RetCam wide-field infant fundus image · image size 640x480:
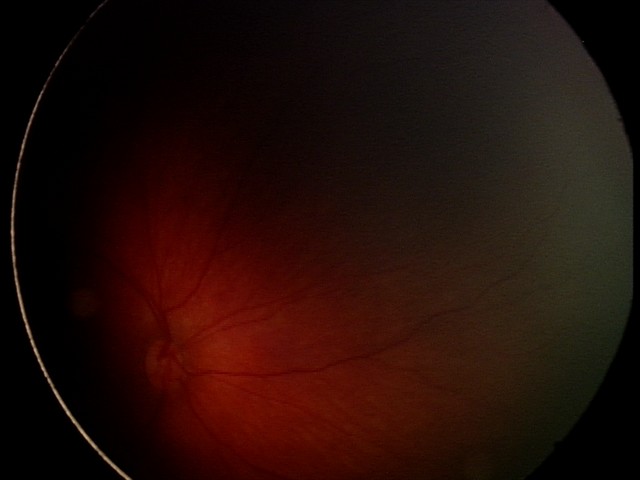 Assessment: retinal hemorrhages.